Wide-field contact fundus photograph of an infant.
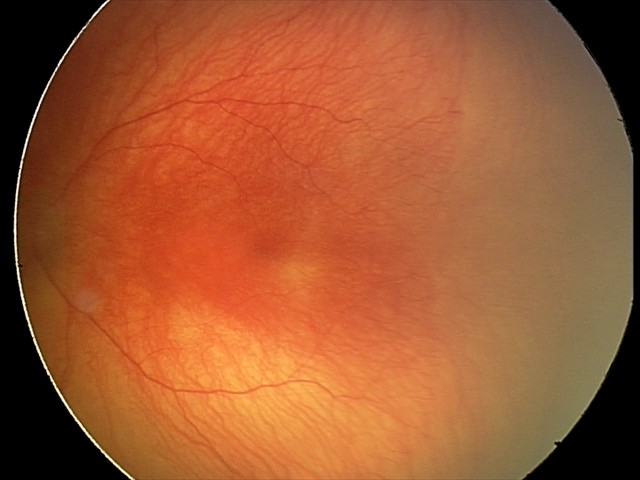
Screening series with A-ROP (aggressive ROP). With plus disease.